Modified Davis grading: 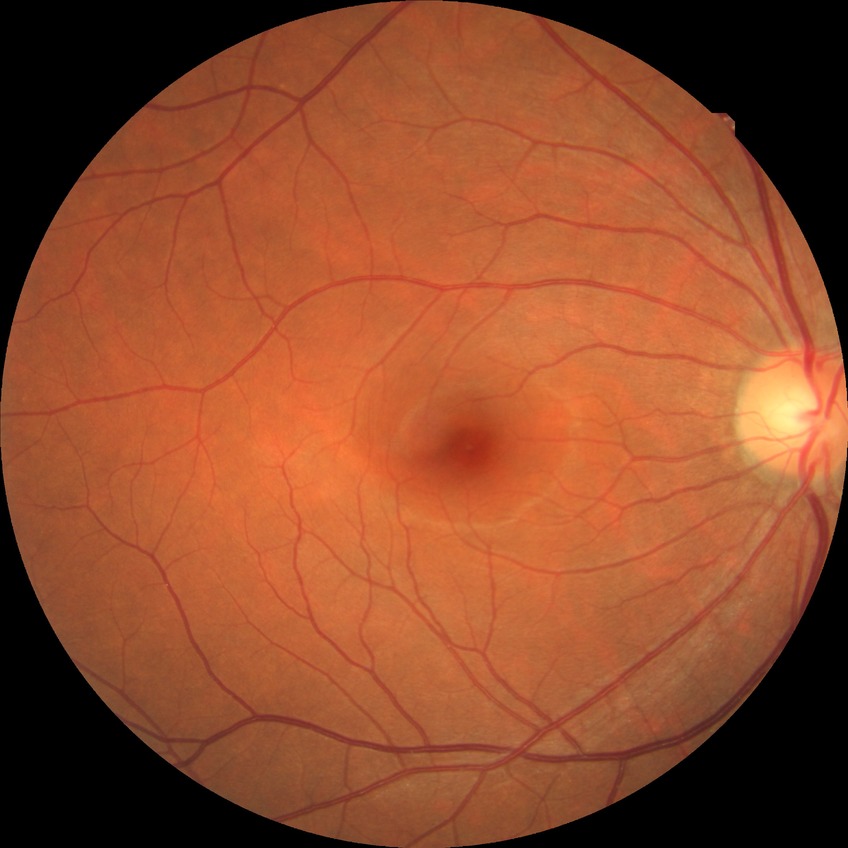

Davis stage is NDR.